Graded on the modified Davis scale.
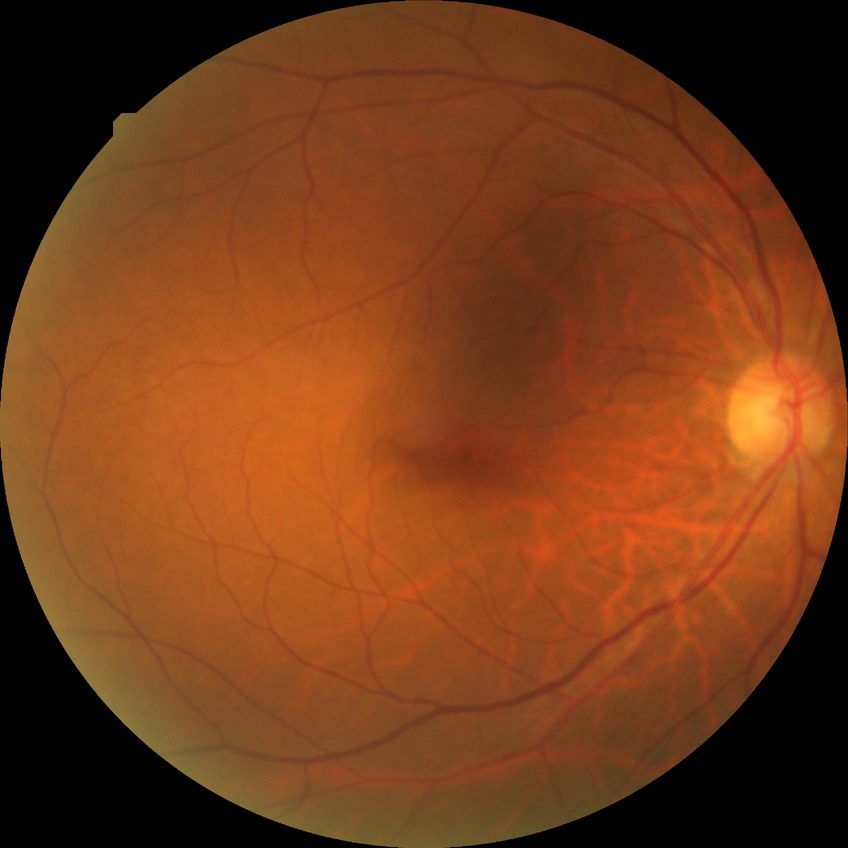 diabetic retinopathy (DR): NDR (no diabetic retinopathy).